Wide-field fundus photograph of an infant · 130° field of view (Clarity RetCam 3)
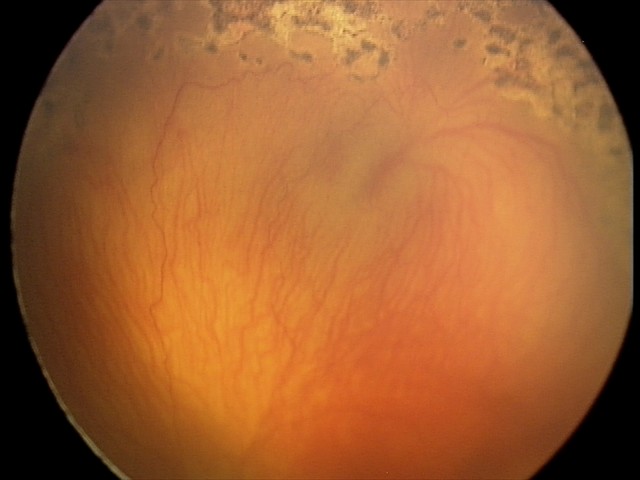
Plus form = present, diagnosis = aggressive retinopathy of prematurity — rapidly progressive severe ROP with prominent plus disease, often without classic stage progression.